Color fundus image:
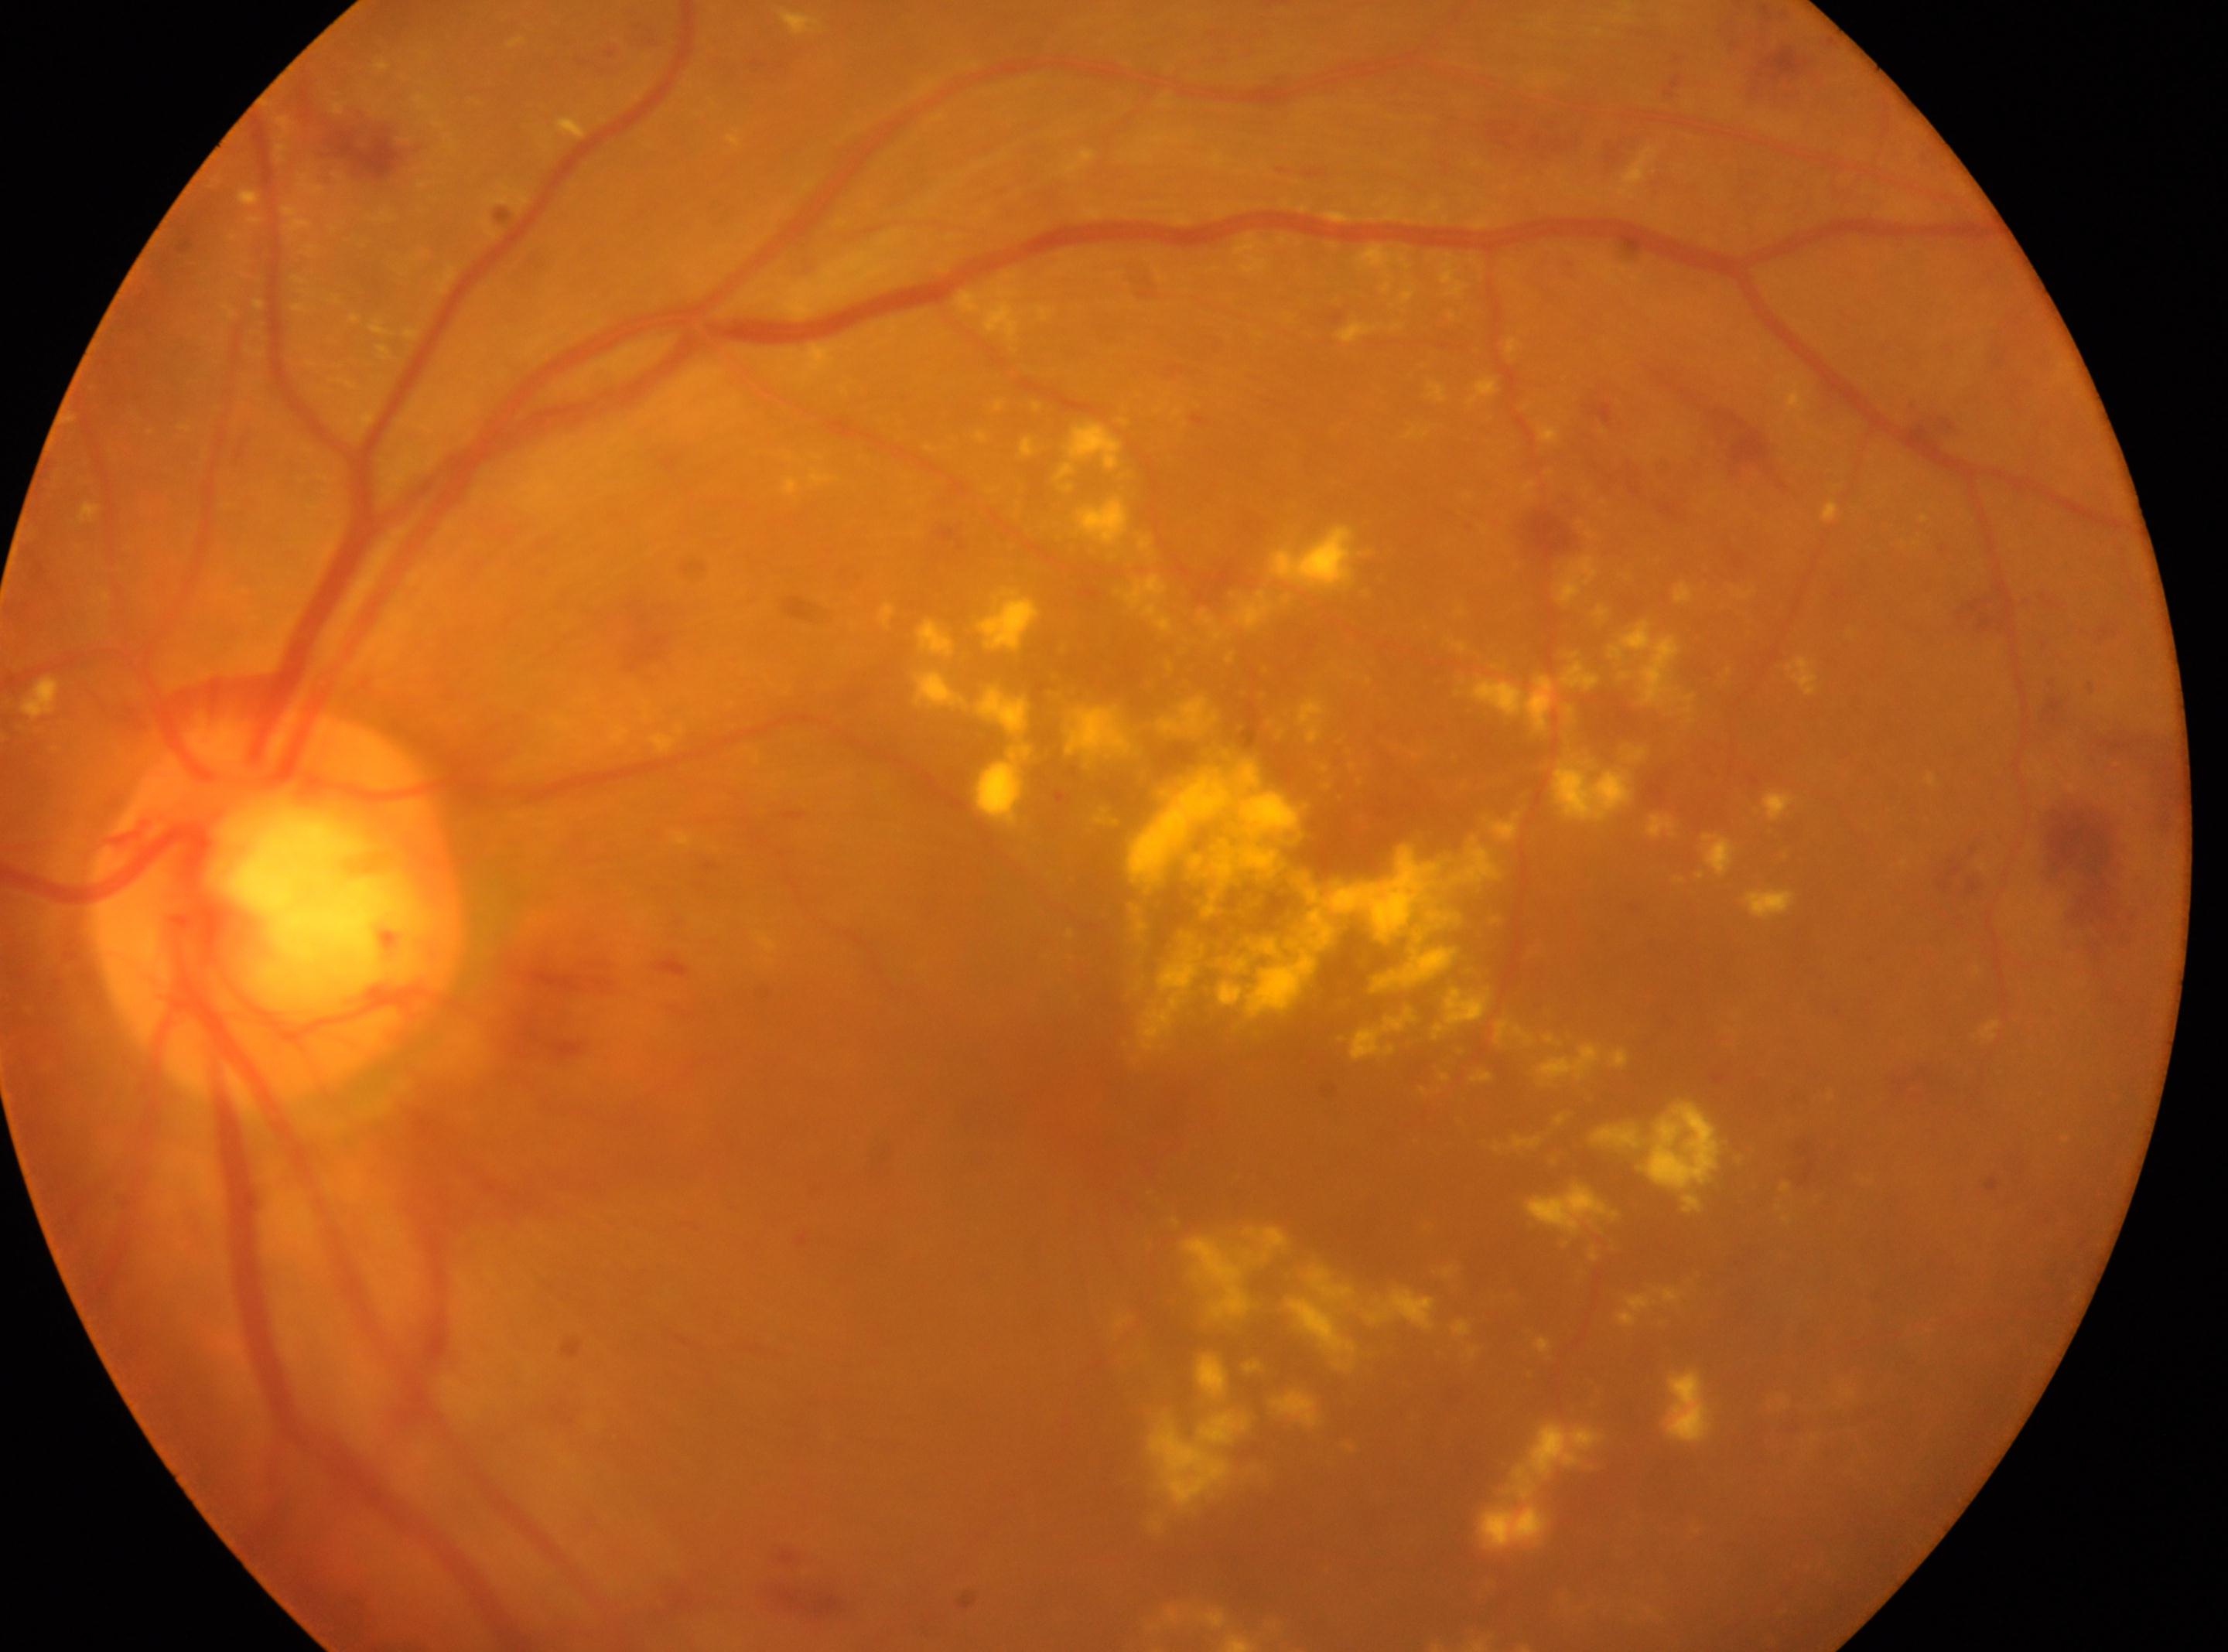
Eye: left. The macula center is at (x: 1071, y: 1108). DR grade is severe NPDR (3). Optic disc located at (x: 276, y: 906).